CFP, 45-degree field of view, NIDEK AFC-230, nonmydriatic, 848x848:
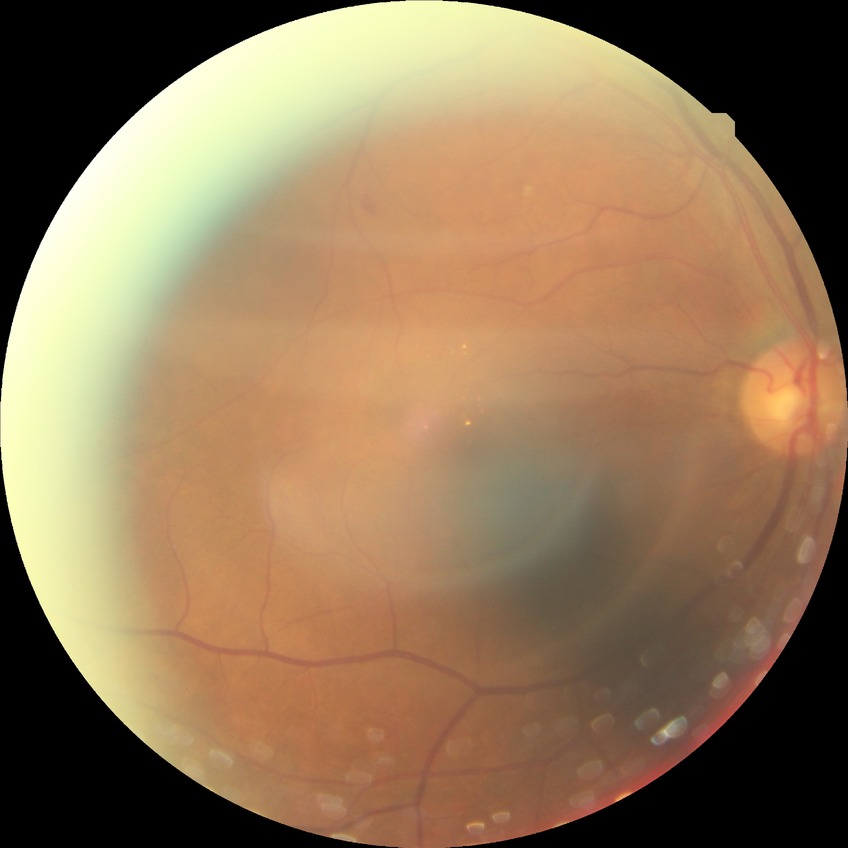

Modified Davis grading: proliferative diabetic retinopathy.